Color fundus image:
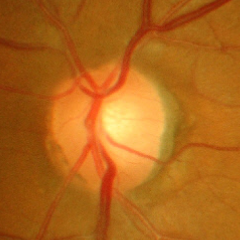
Demonstrates advanced-stage glaucoma.